45-degree field of view, 2352x1568px: 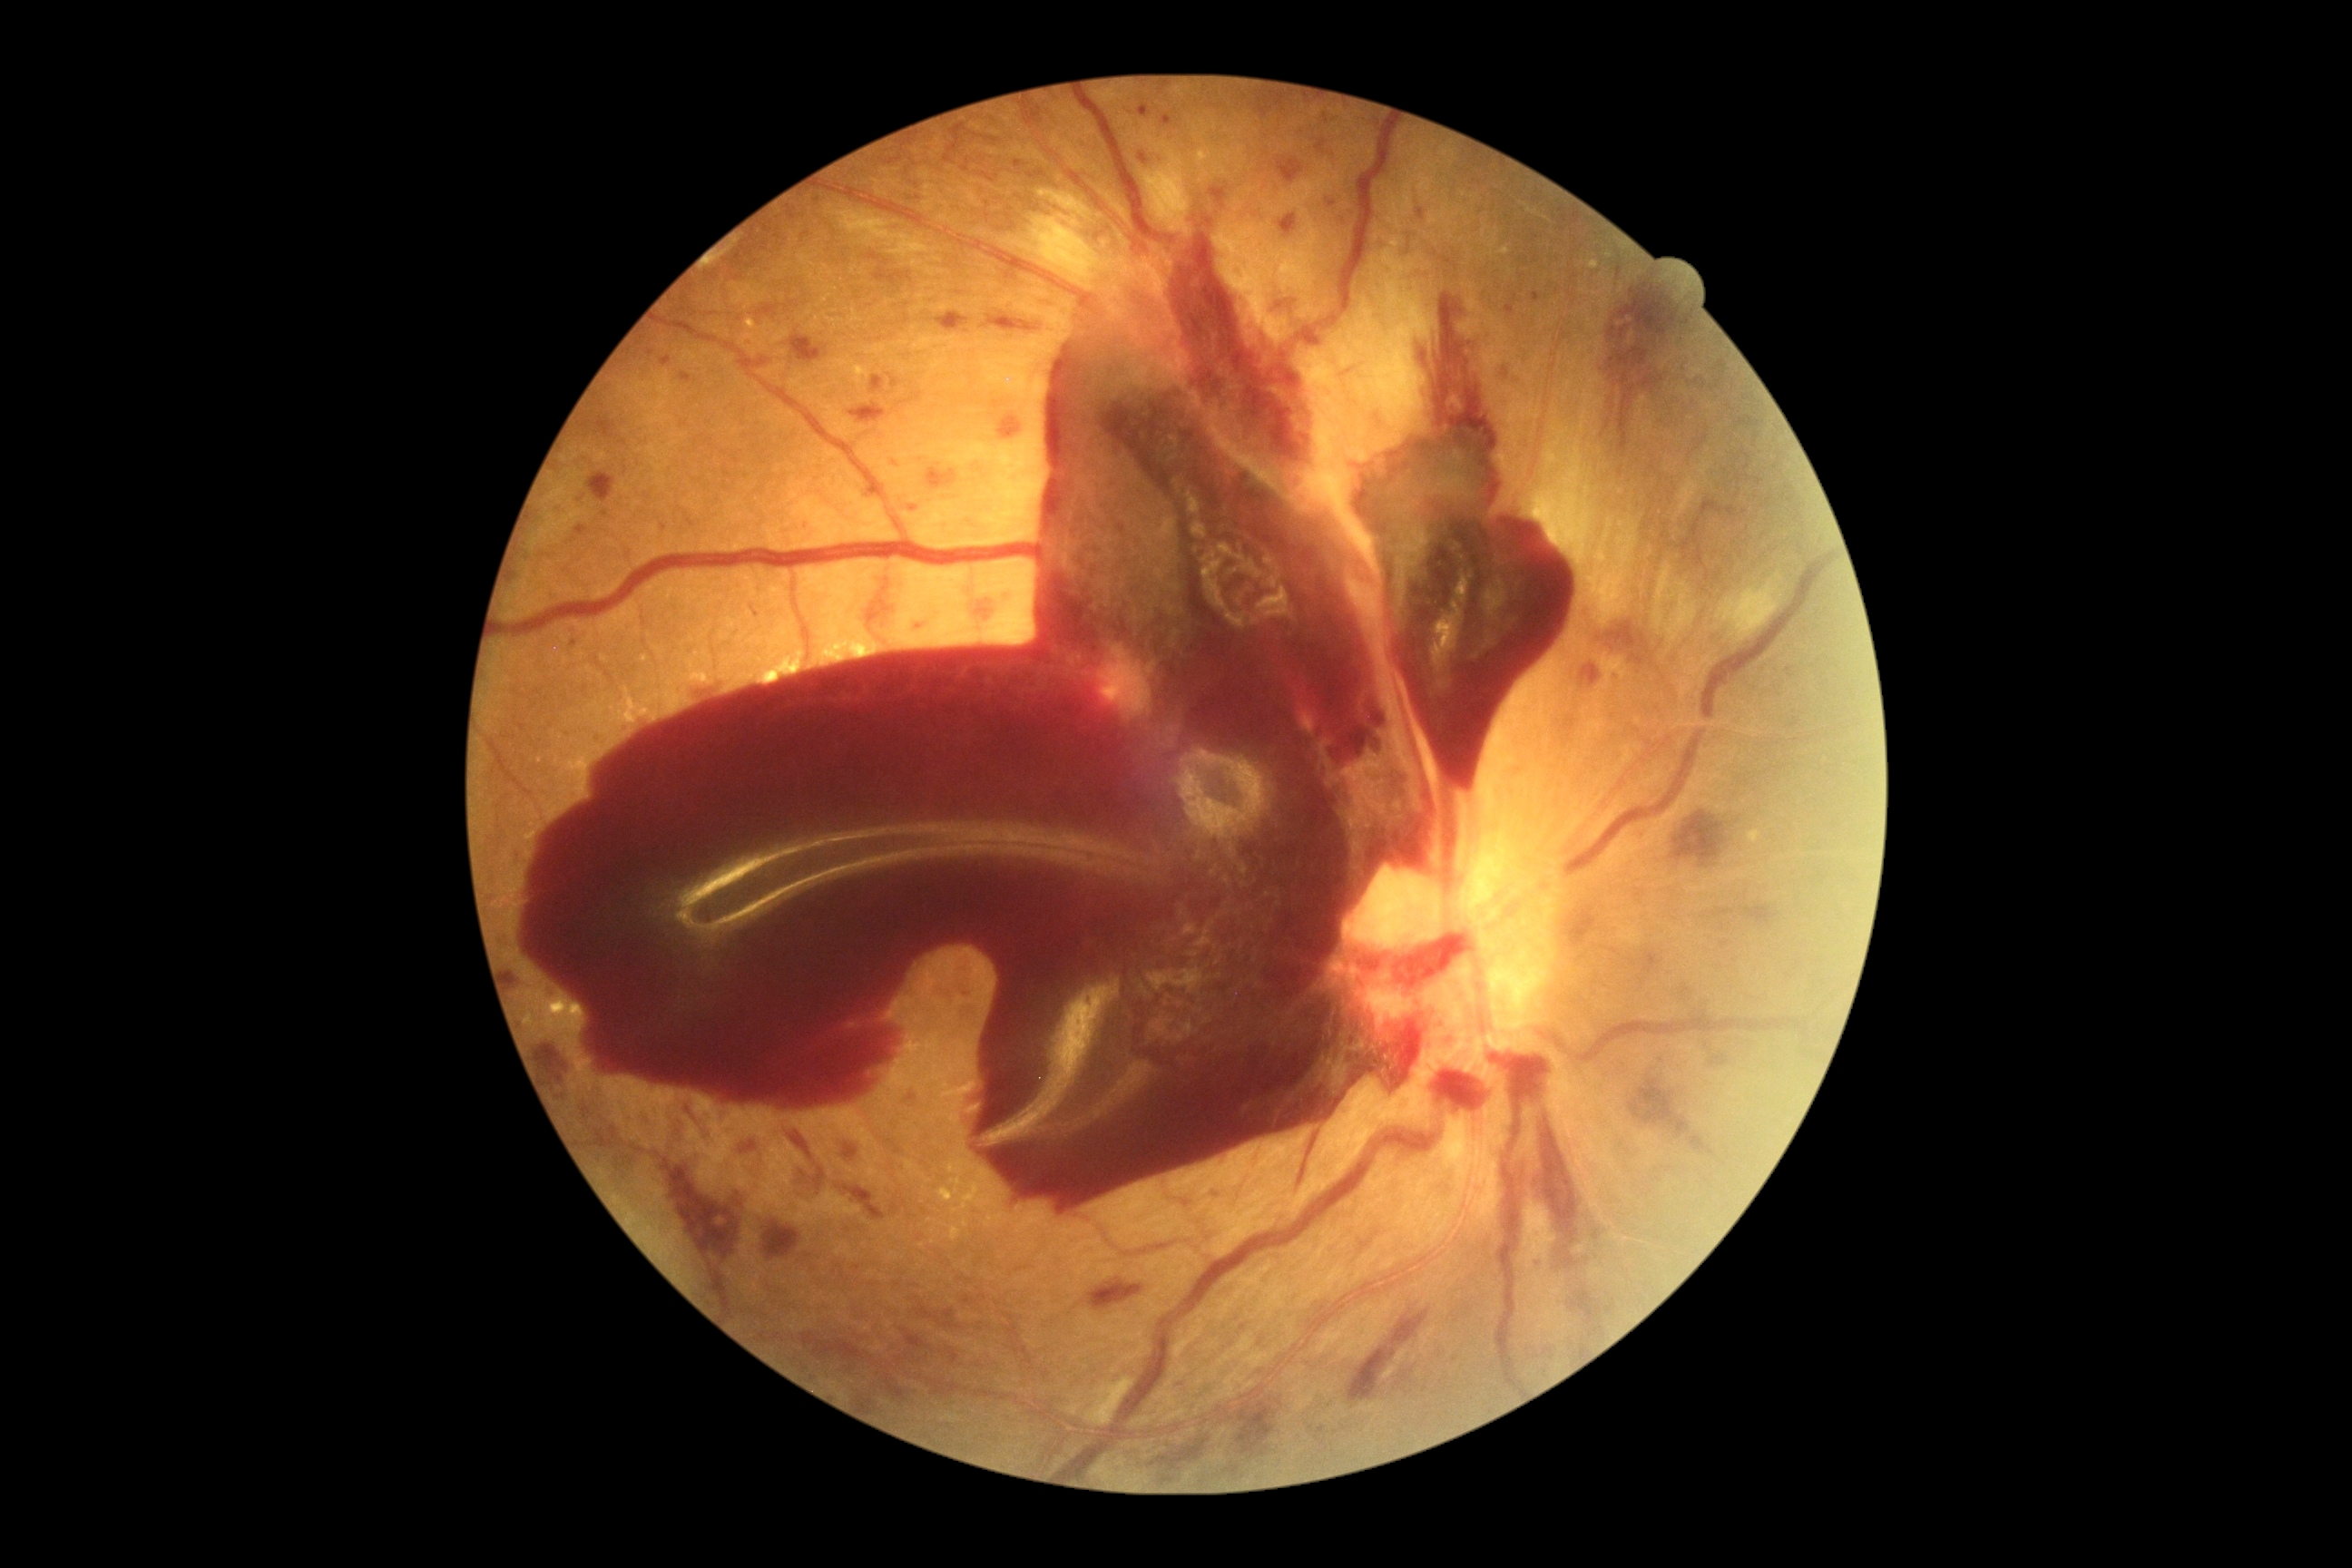 Retinopathy grade: 4 (PDR).